Wide-field fundus image from infant ROP screening: 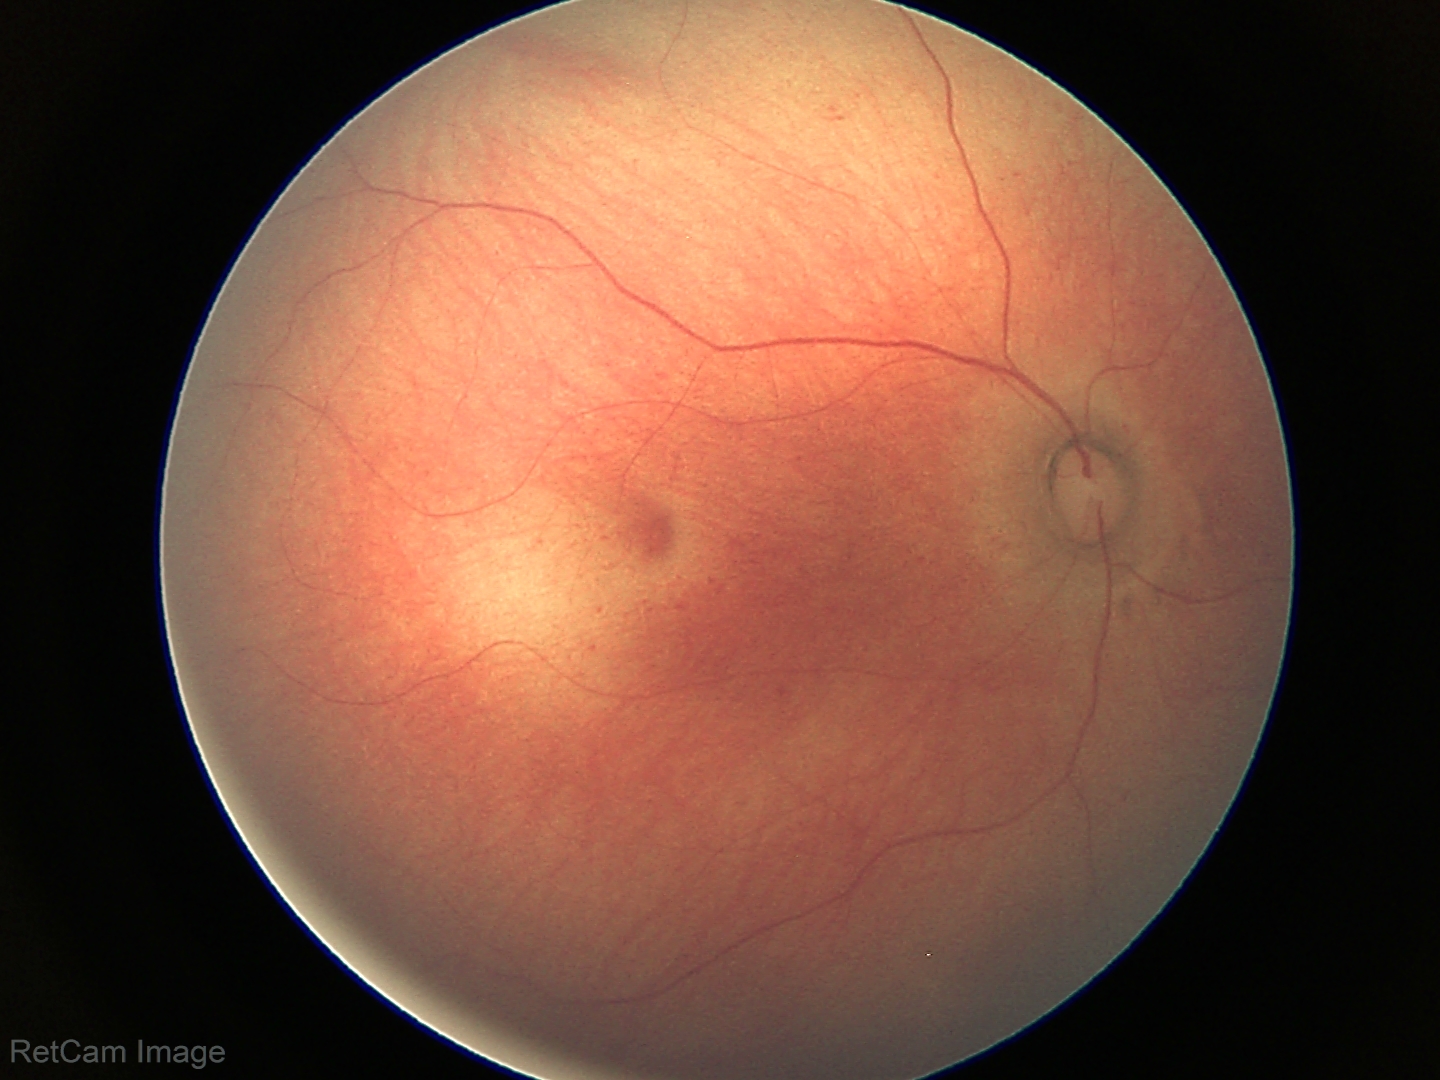 Normal screening examination.